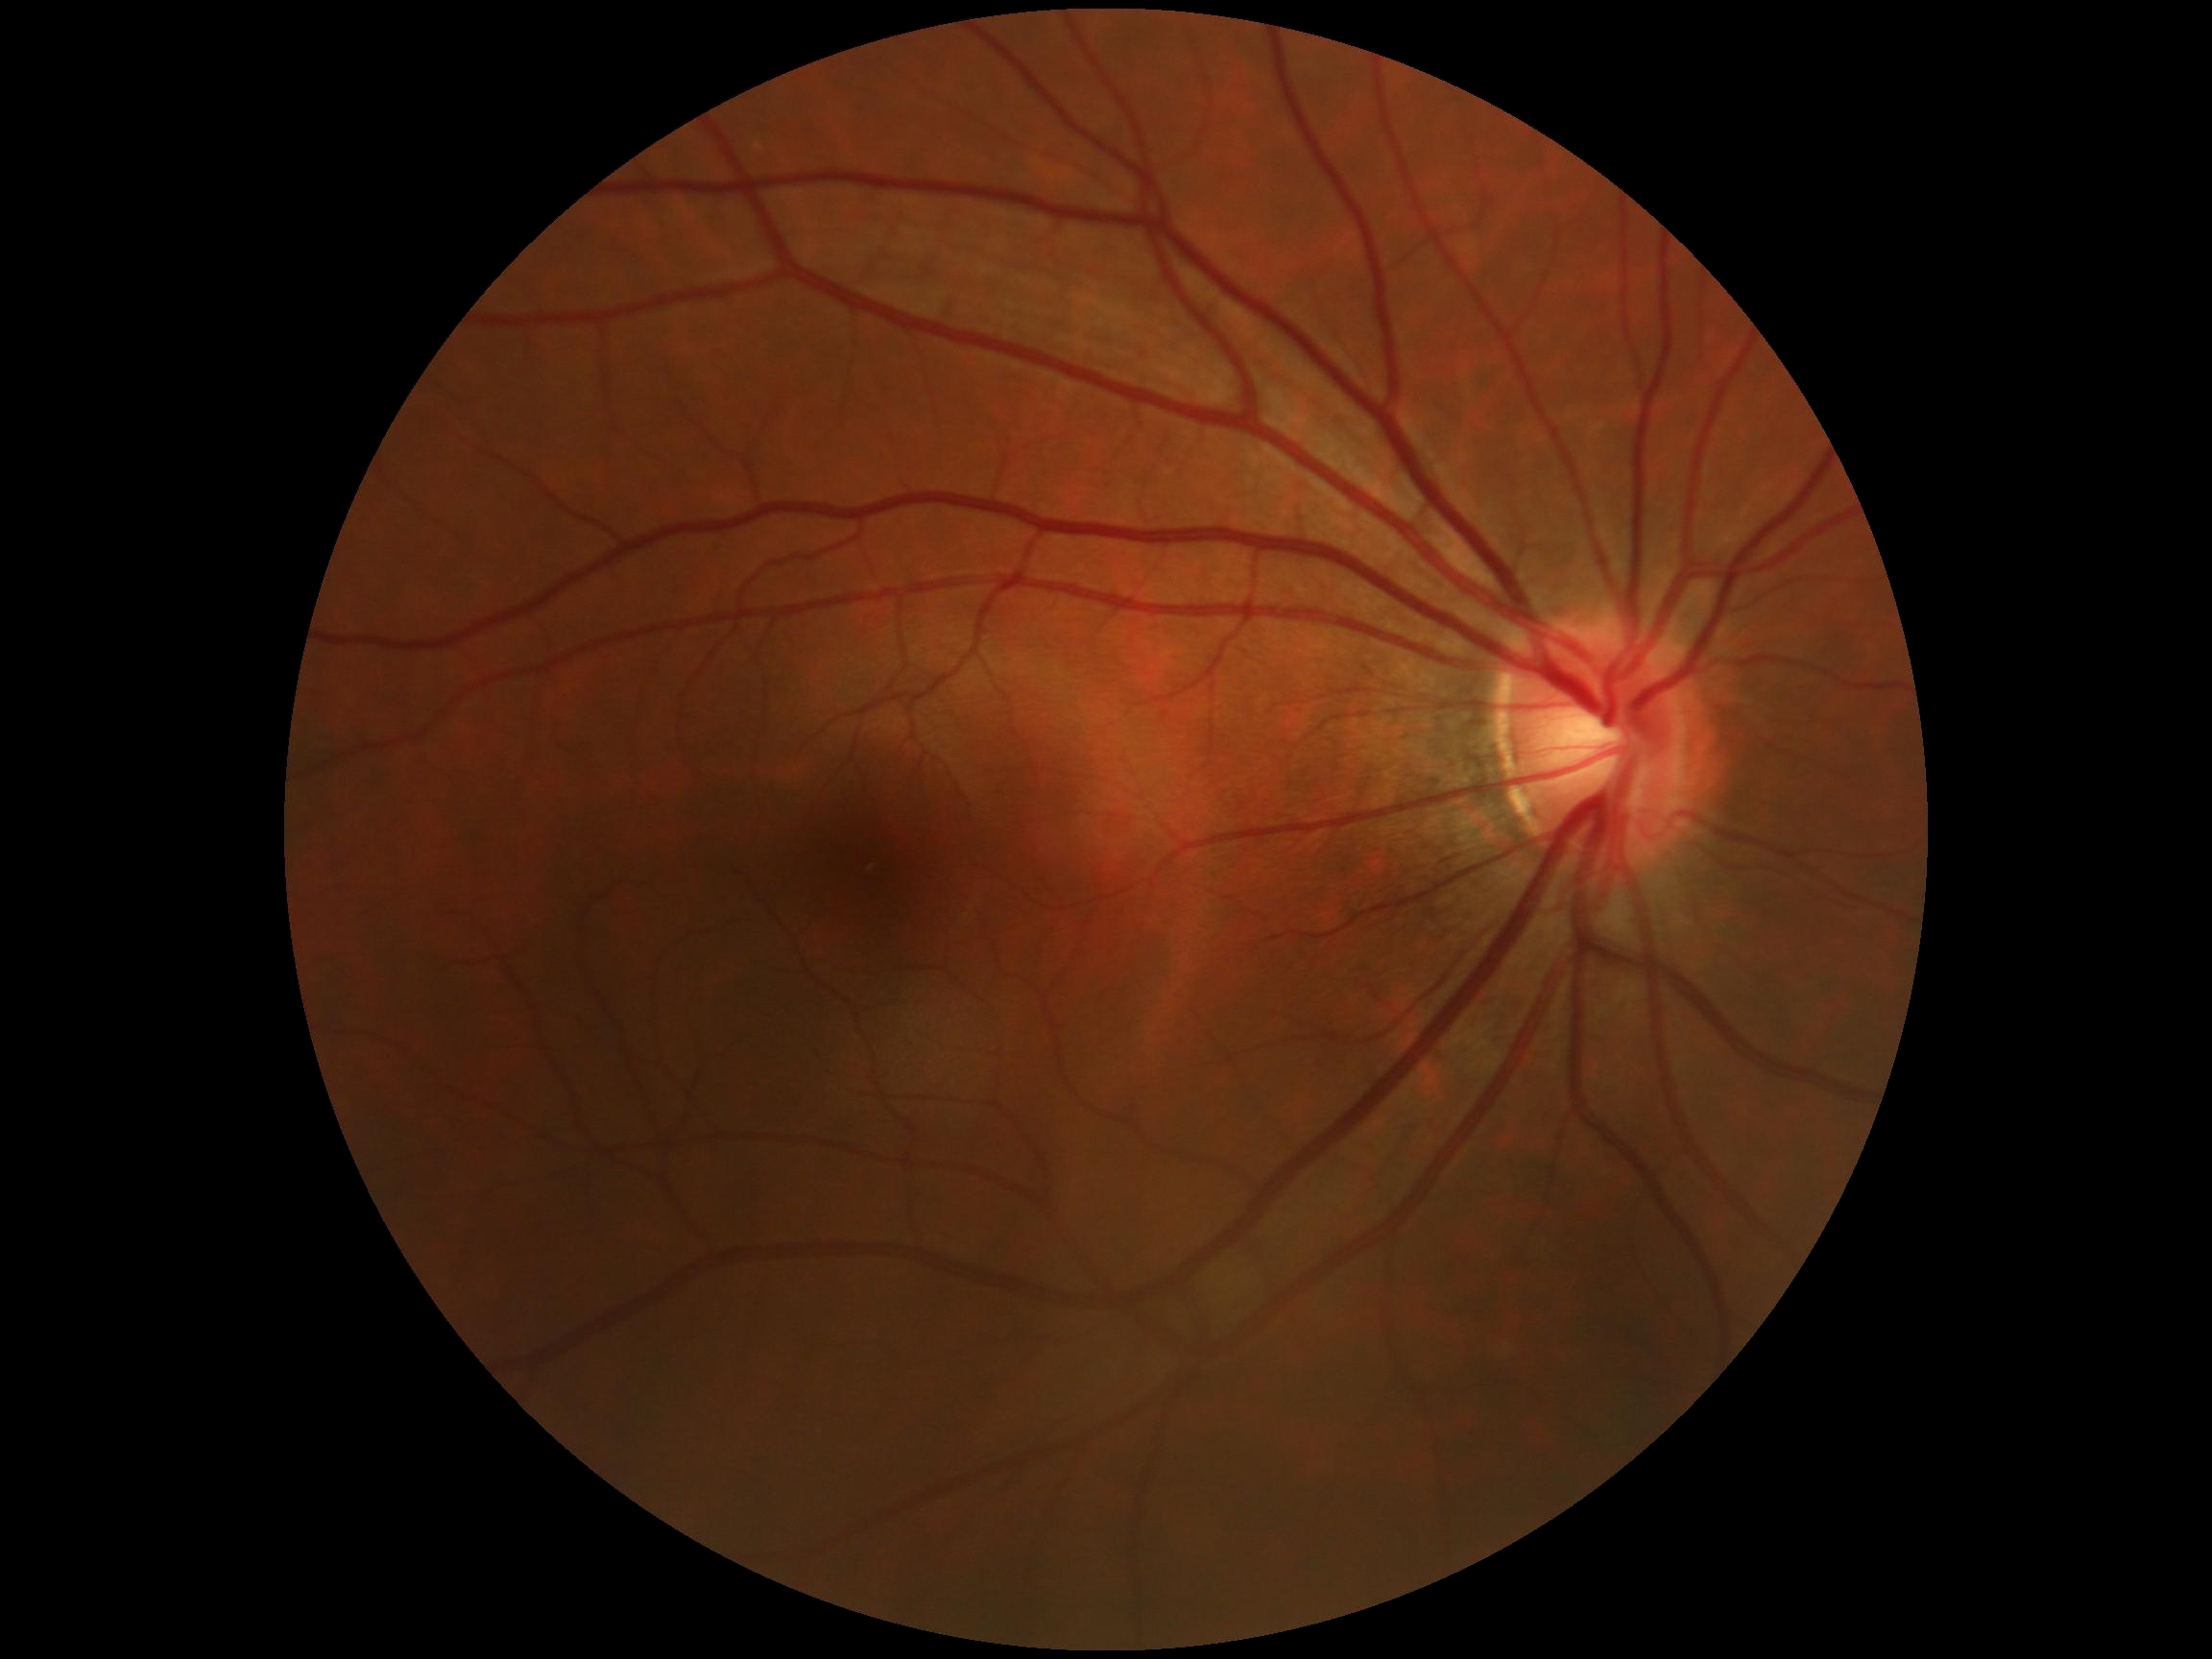

diabetic retinopathy@no apparent diabetic retinopathy (grade 0).